Wide-field fundus photograph from neonatal ROP screening; captured with the Phoenix ICON (100° field of view):
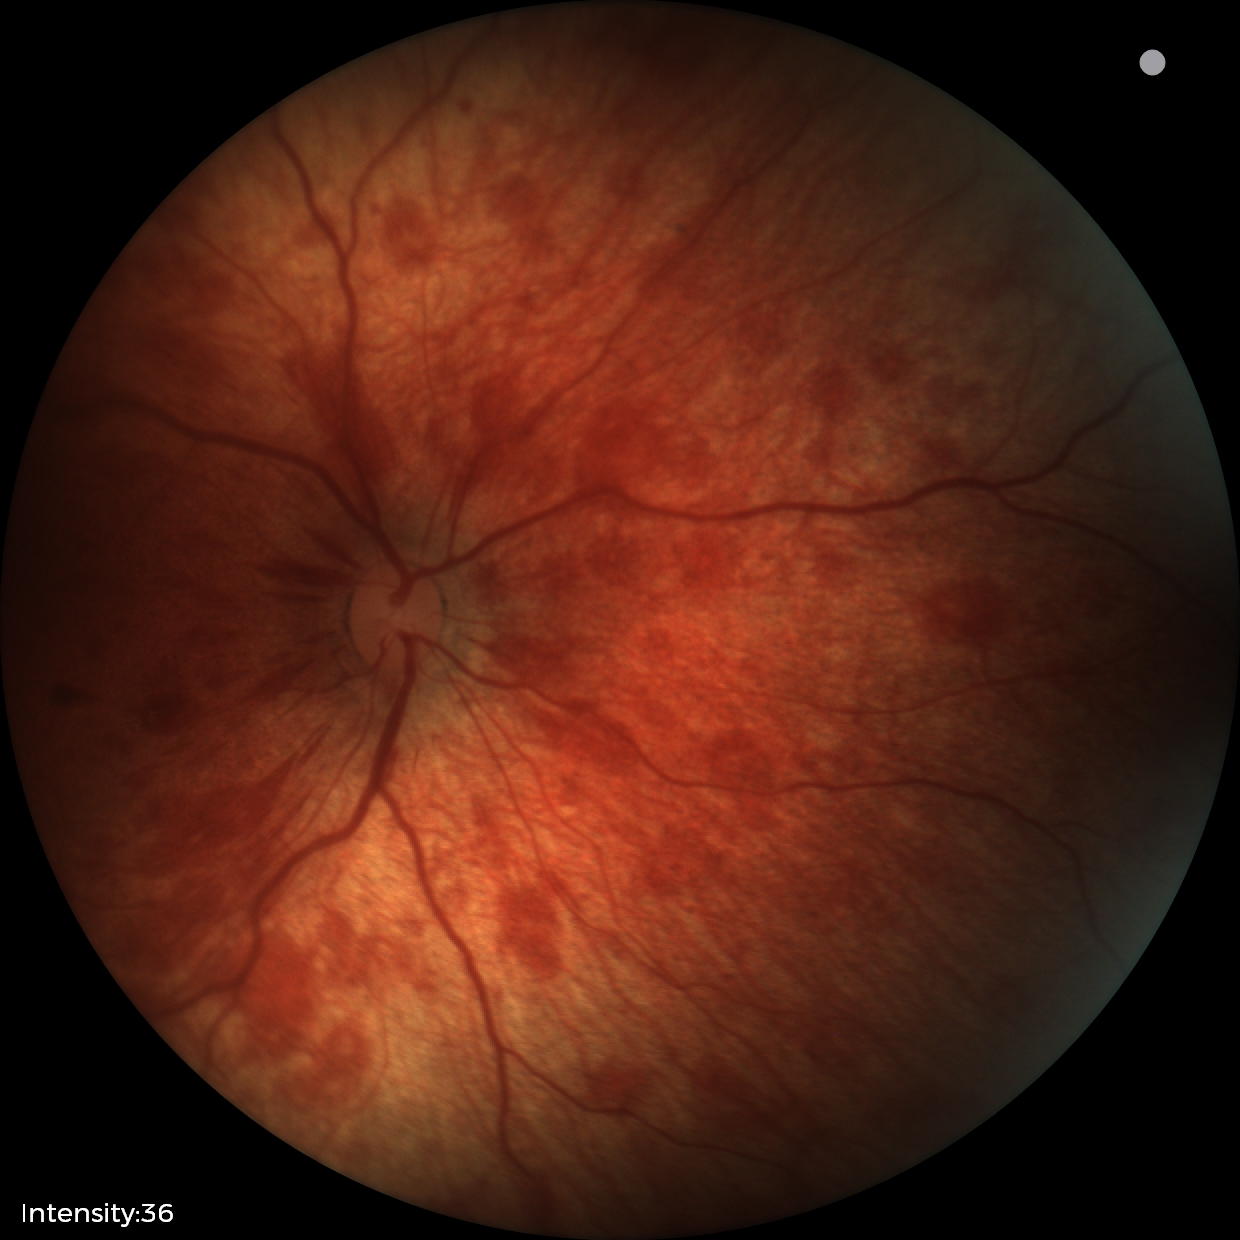

Assessment: retinal hemorrhages.